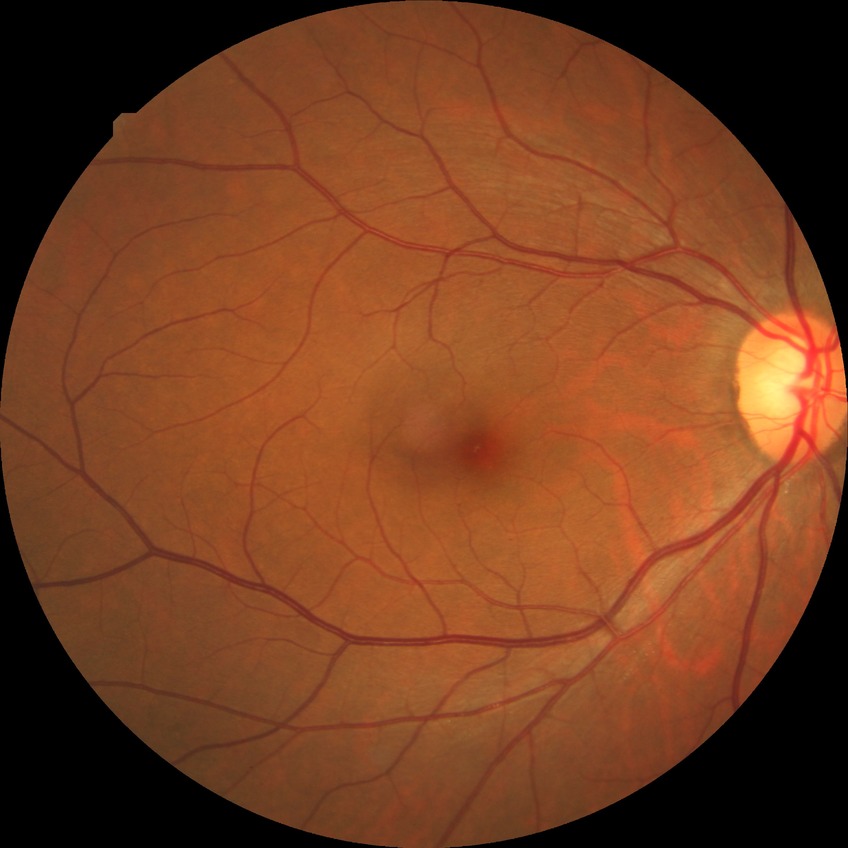

Findings:
– Davis stage — NDR